FOV: 45 degrees, diabetic retinopathy graded by the modified Davis classification, camera: NIDEK AFC-230: 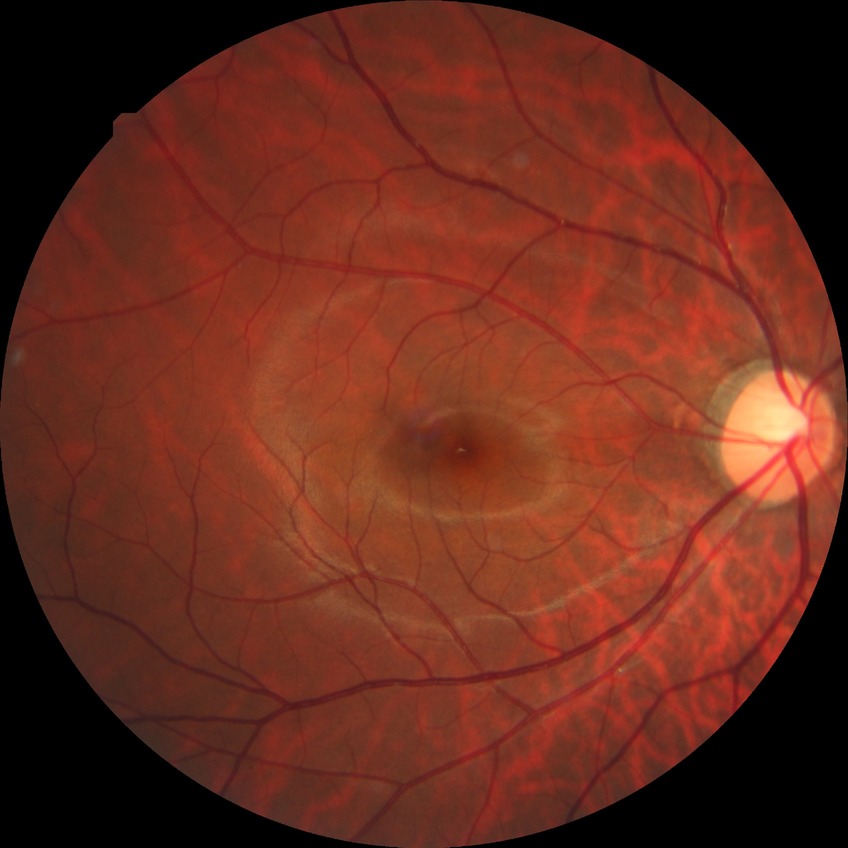

retinopathy stage=no diabetic retinopathy.